45° field of view
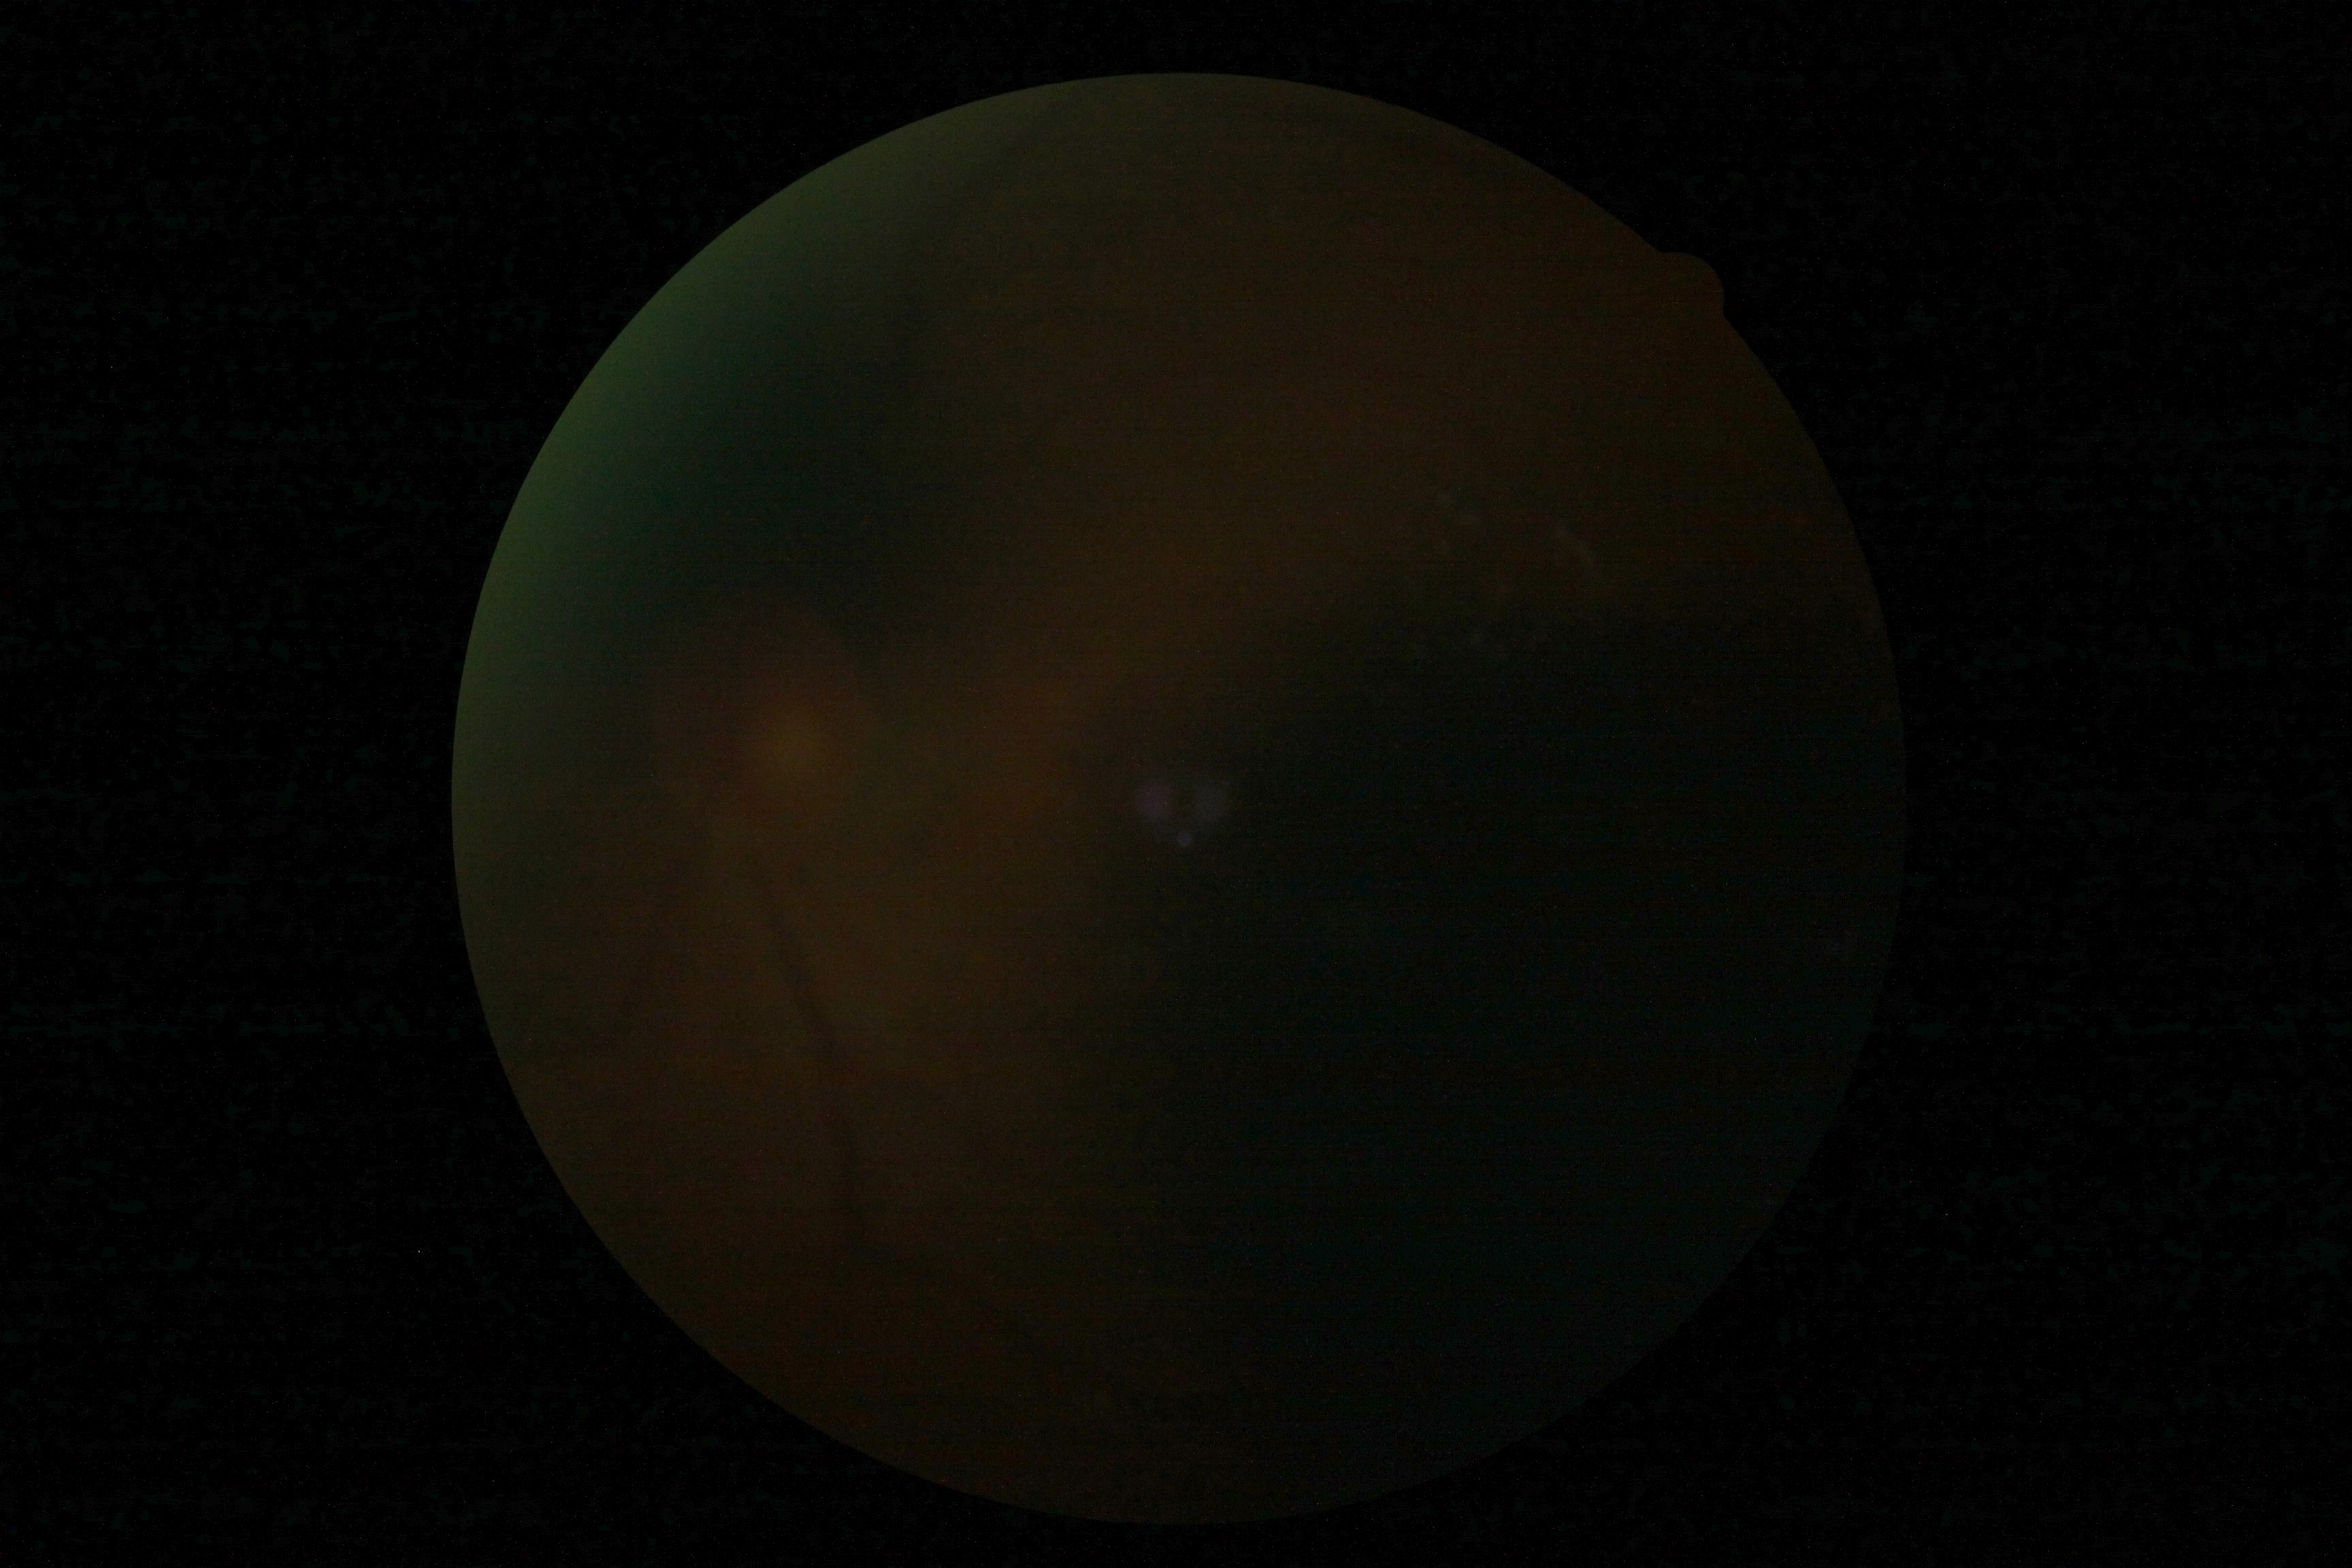 – DR severity — ungradable
– image quality — below grading threshold